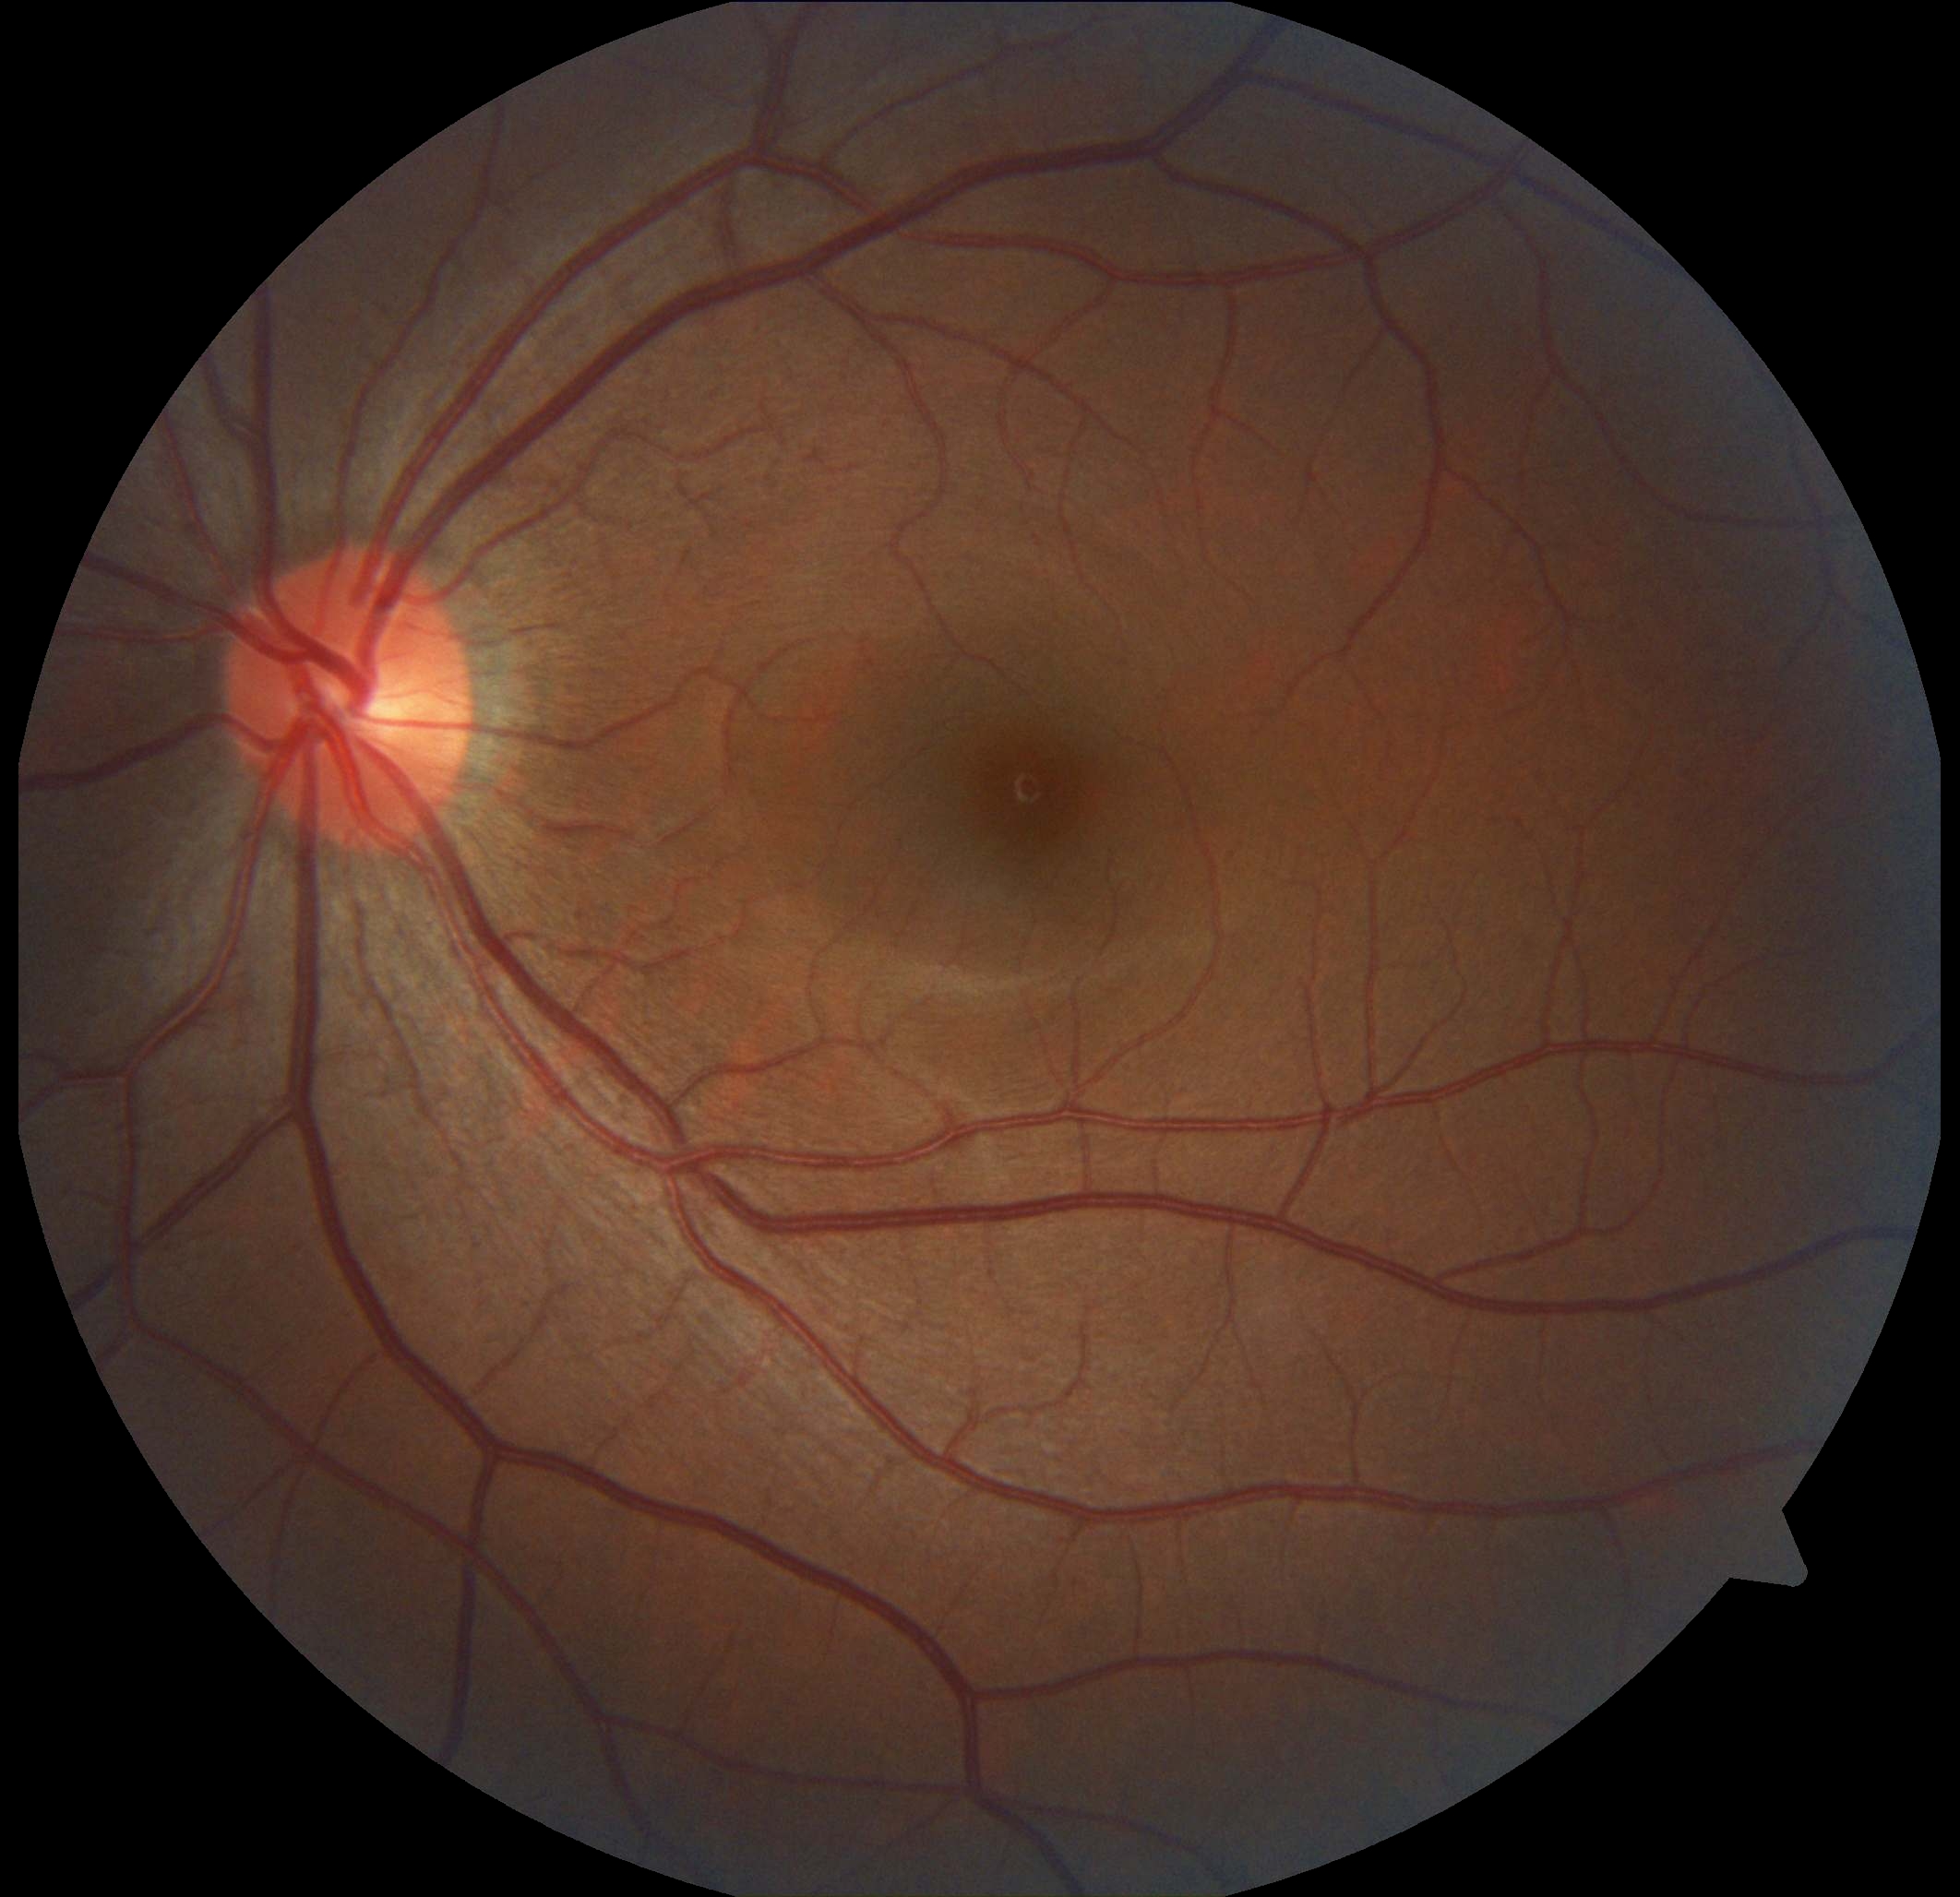 No diabetic retinal disease findings. Diabetic retinopathy grade is 0.